45-degree field of view · image size 1725x1721 · color fundus photograph
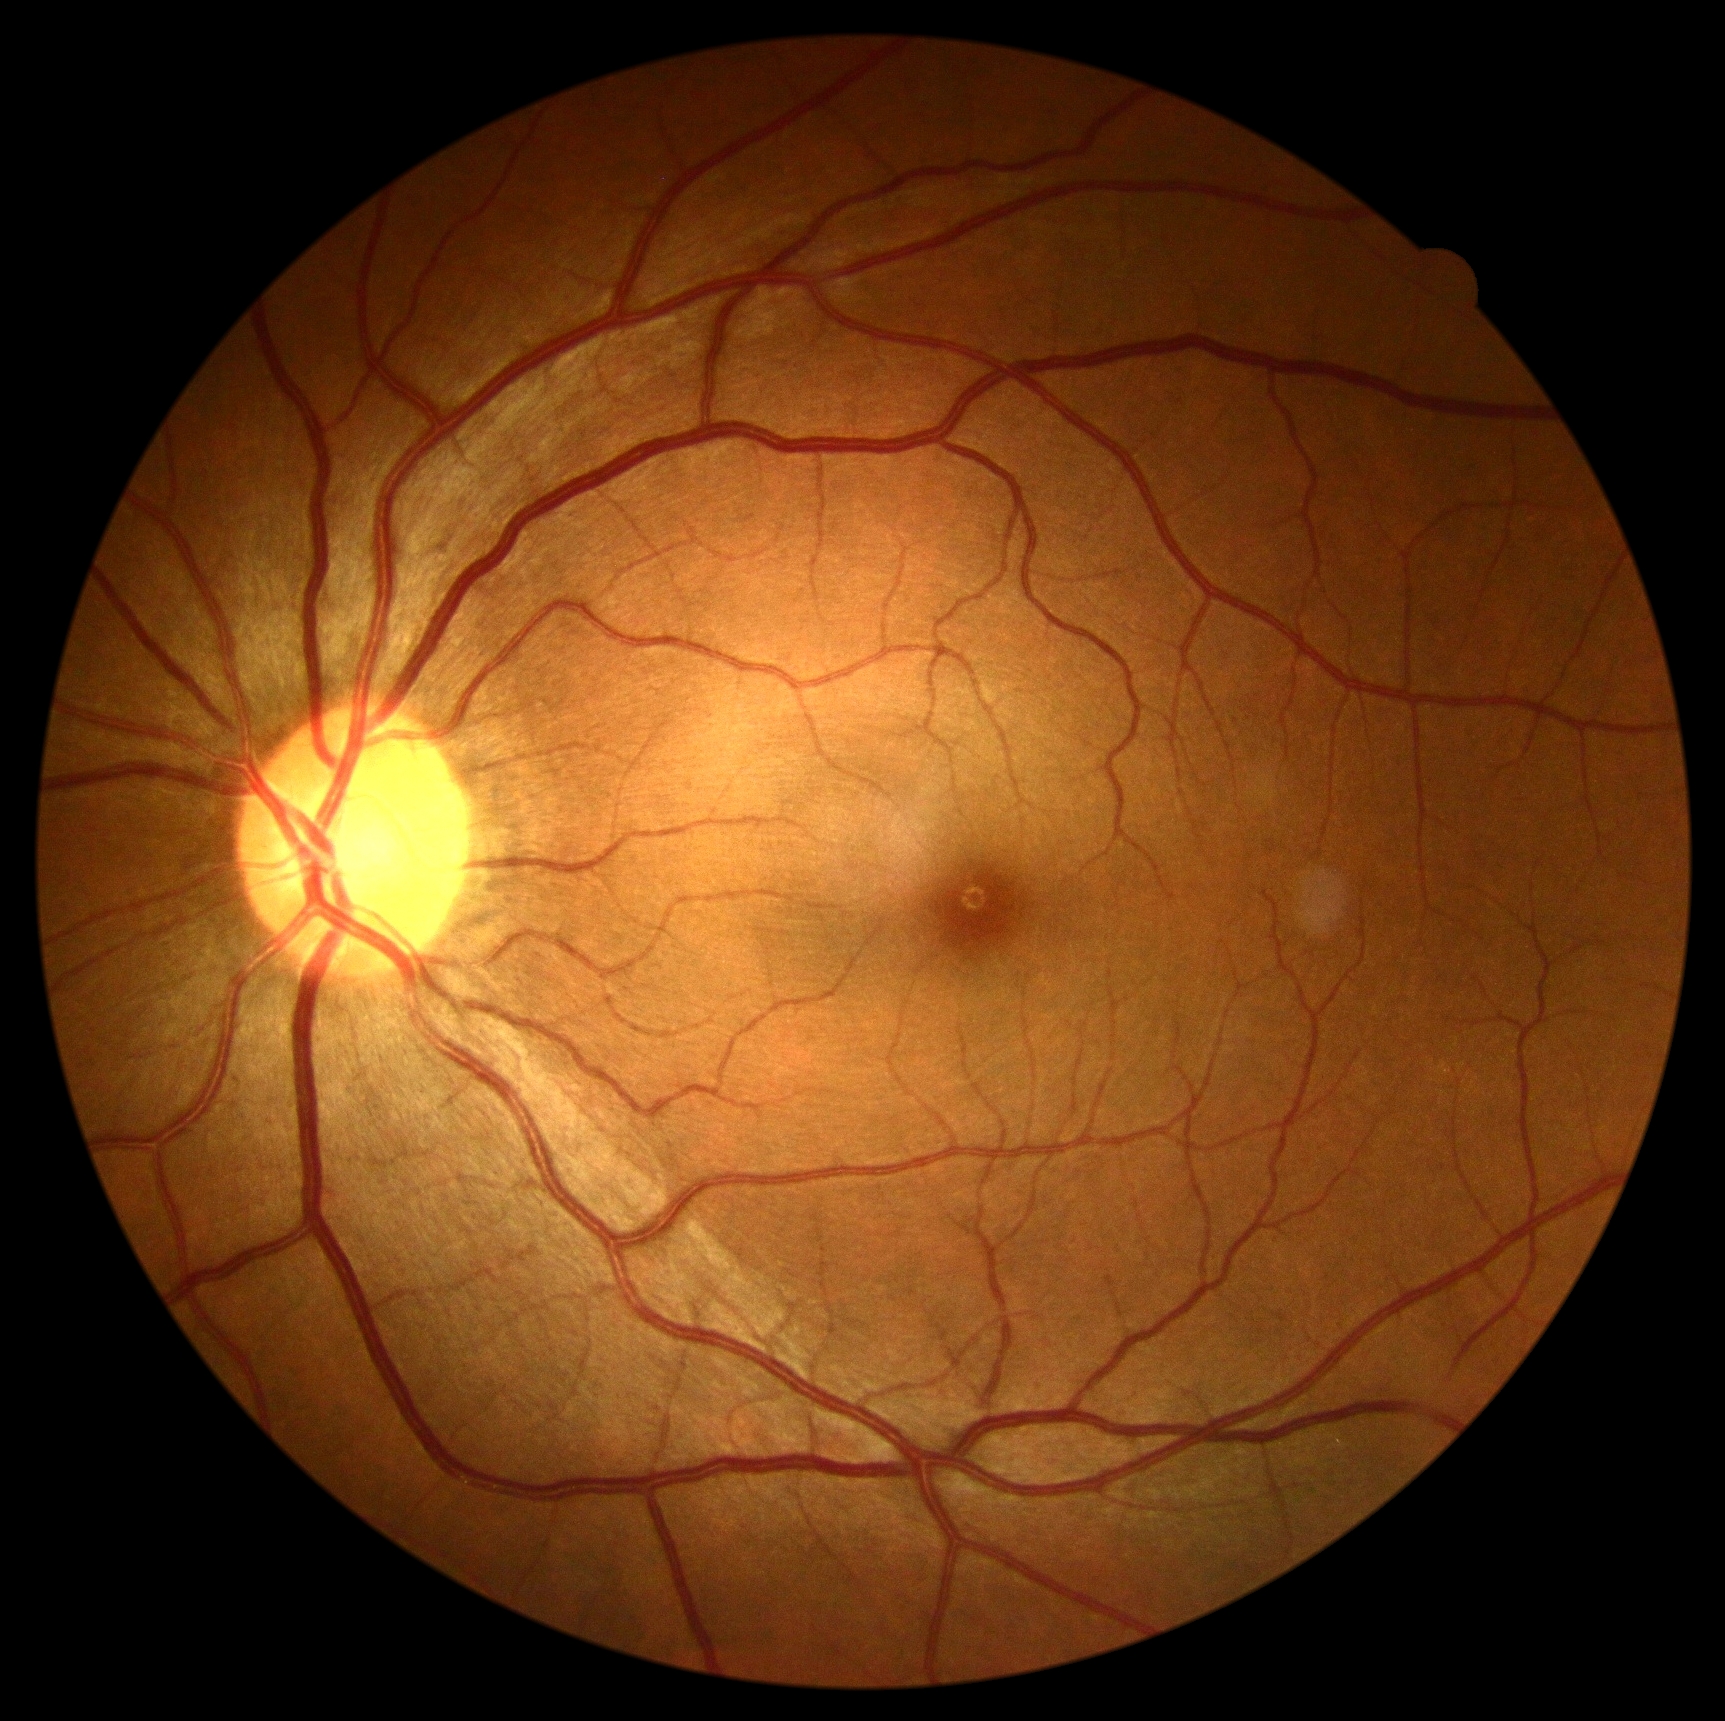
Diabetic retinopathy is no apparent retinopathy (grade 0).